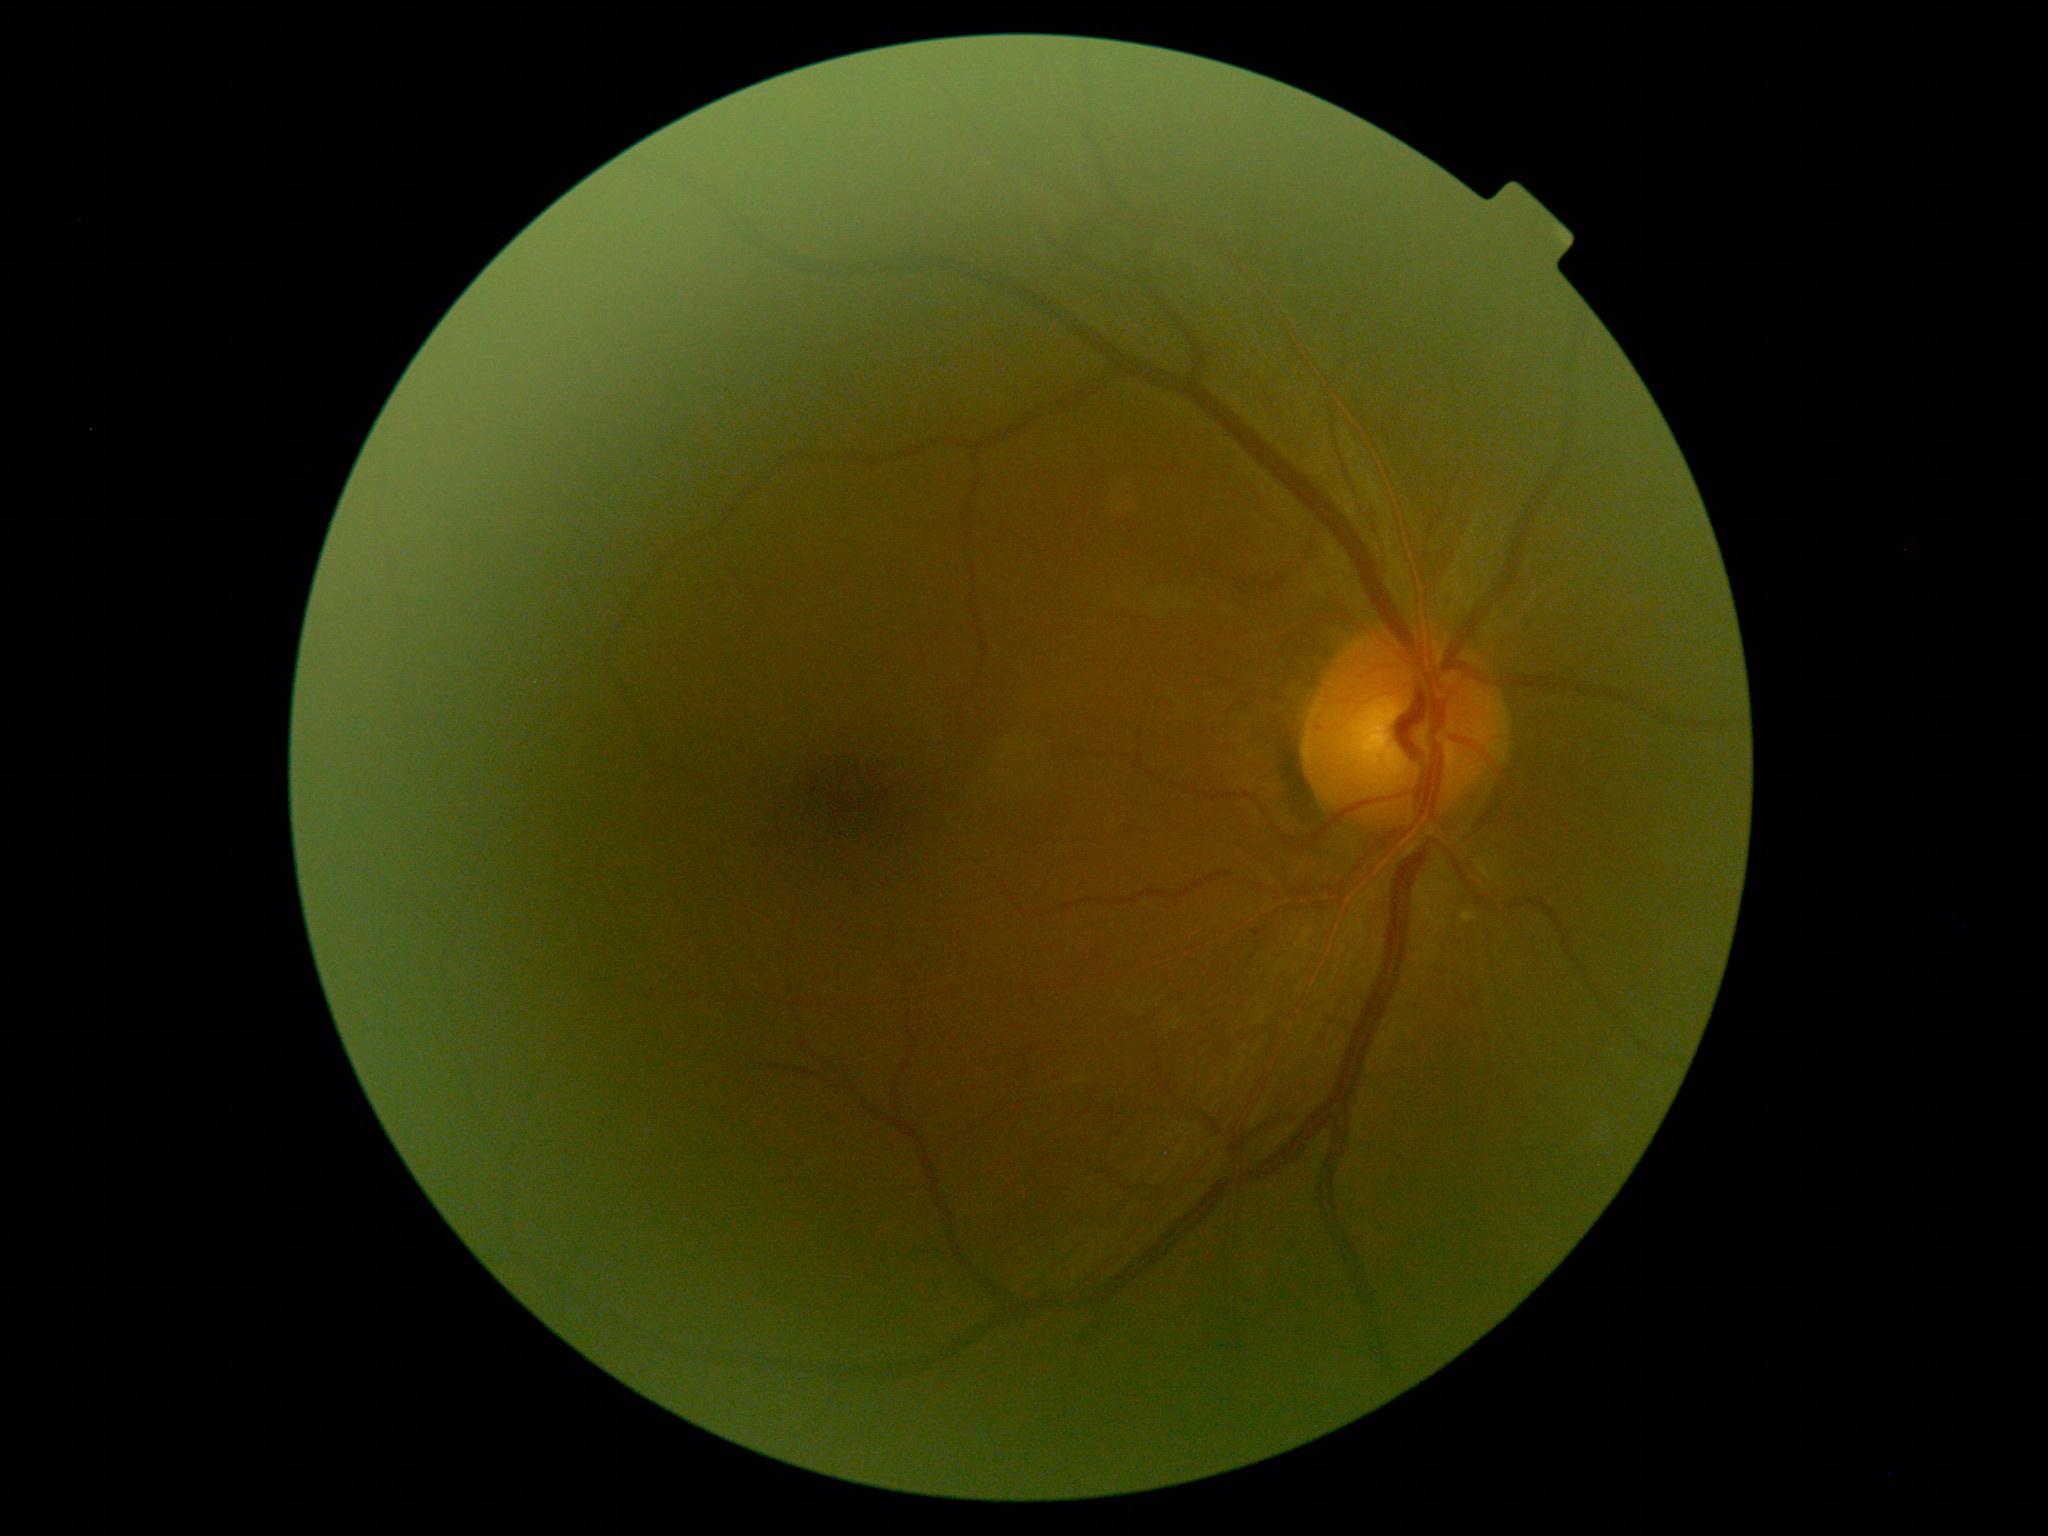

DR is no apparent diabetic retinopathy (grade 0).